CFP. 2352x1568px: 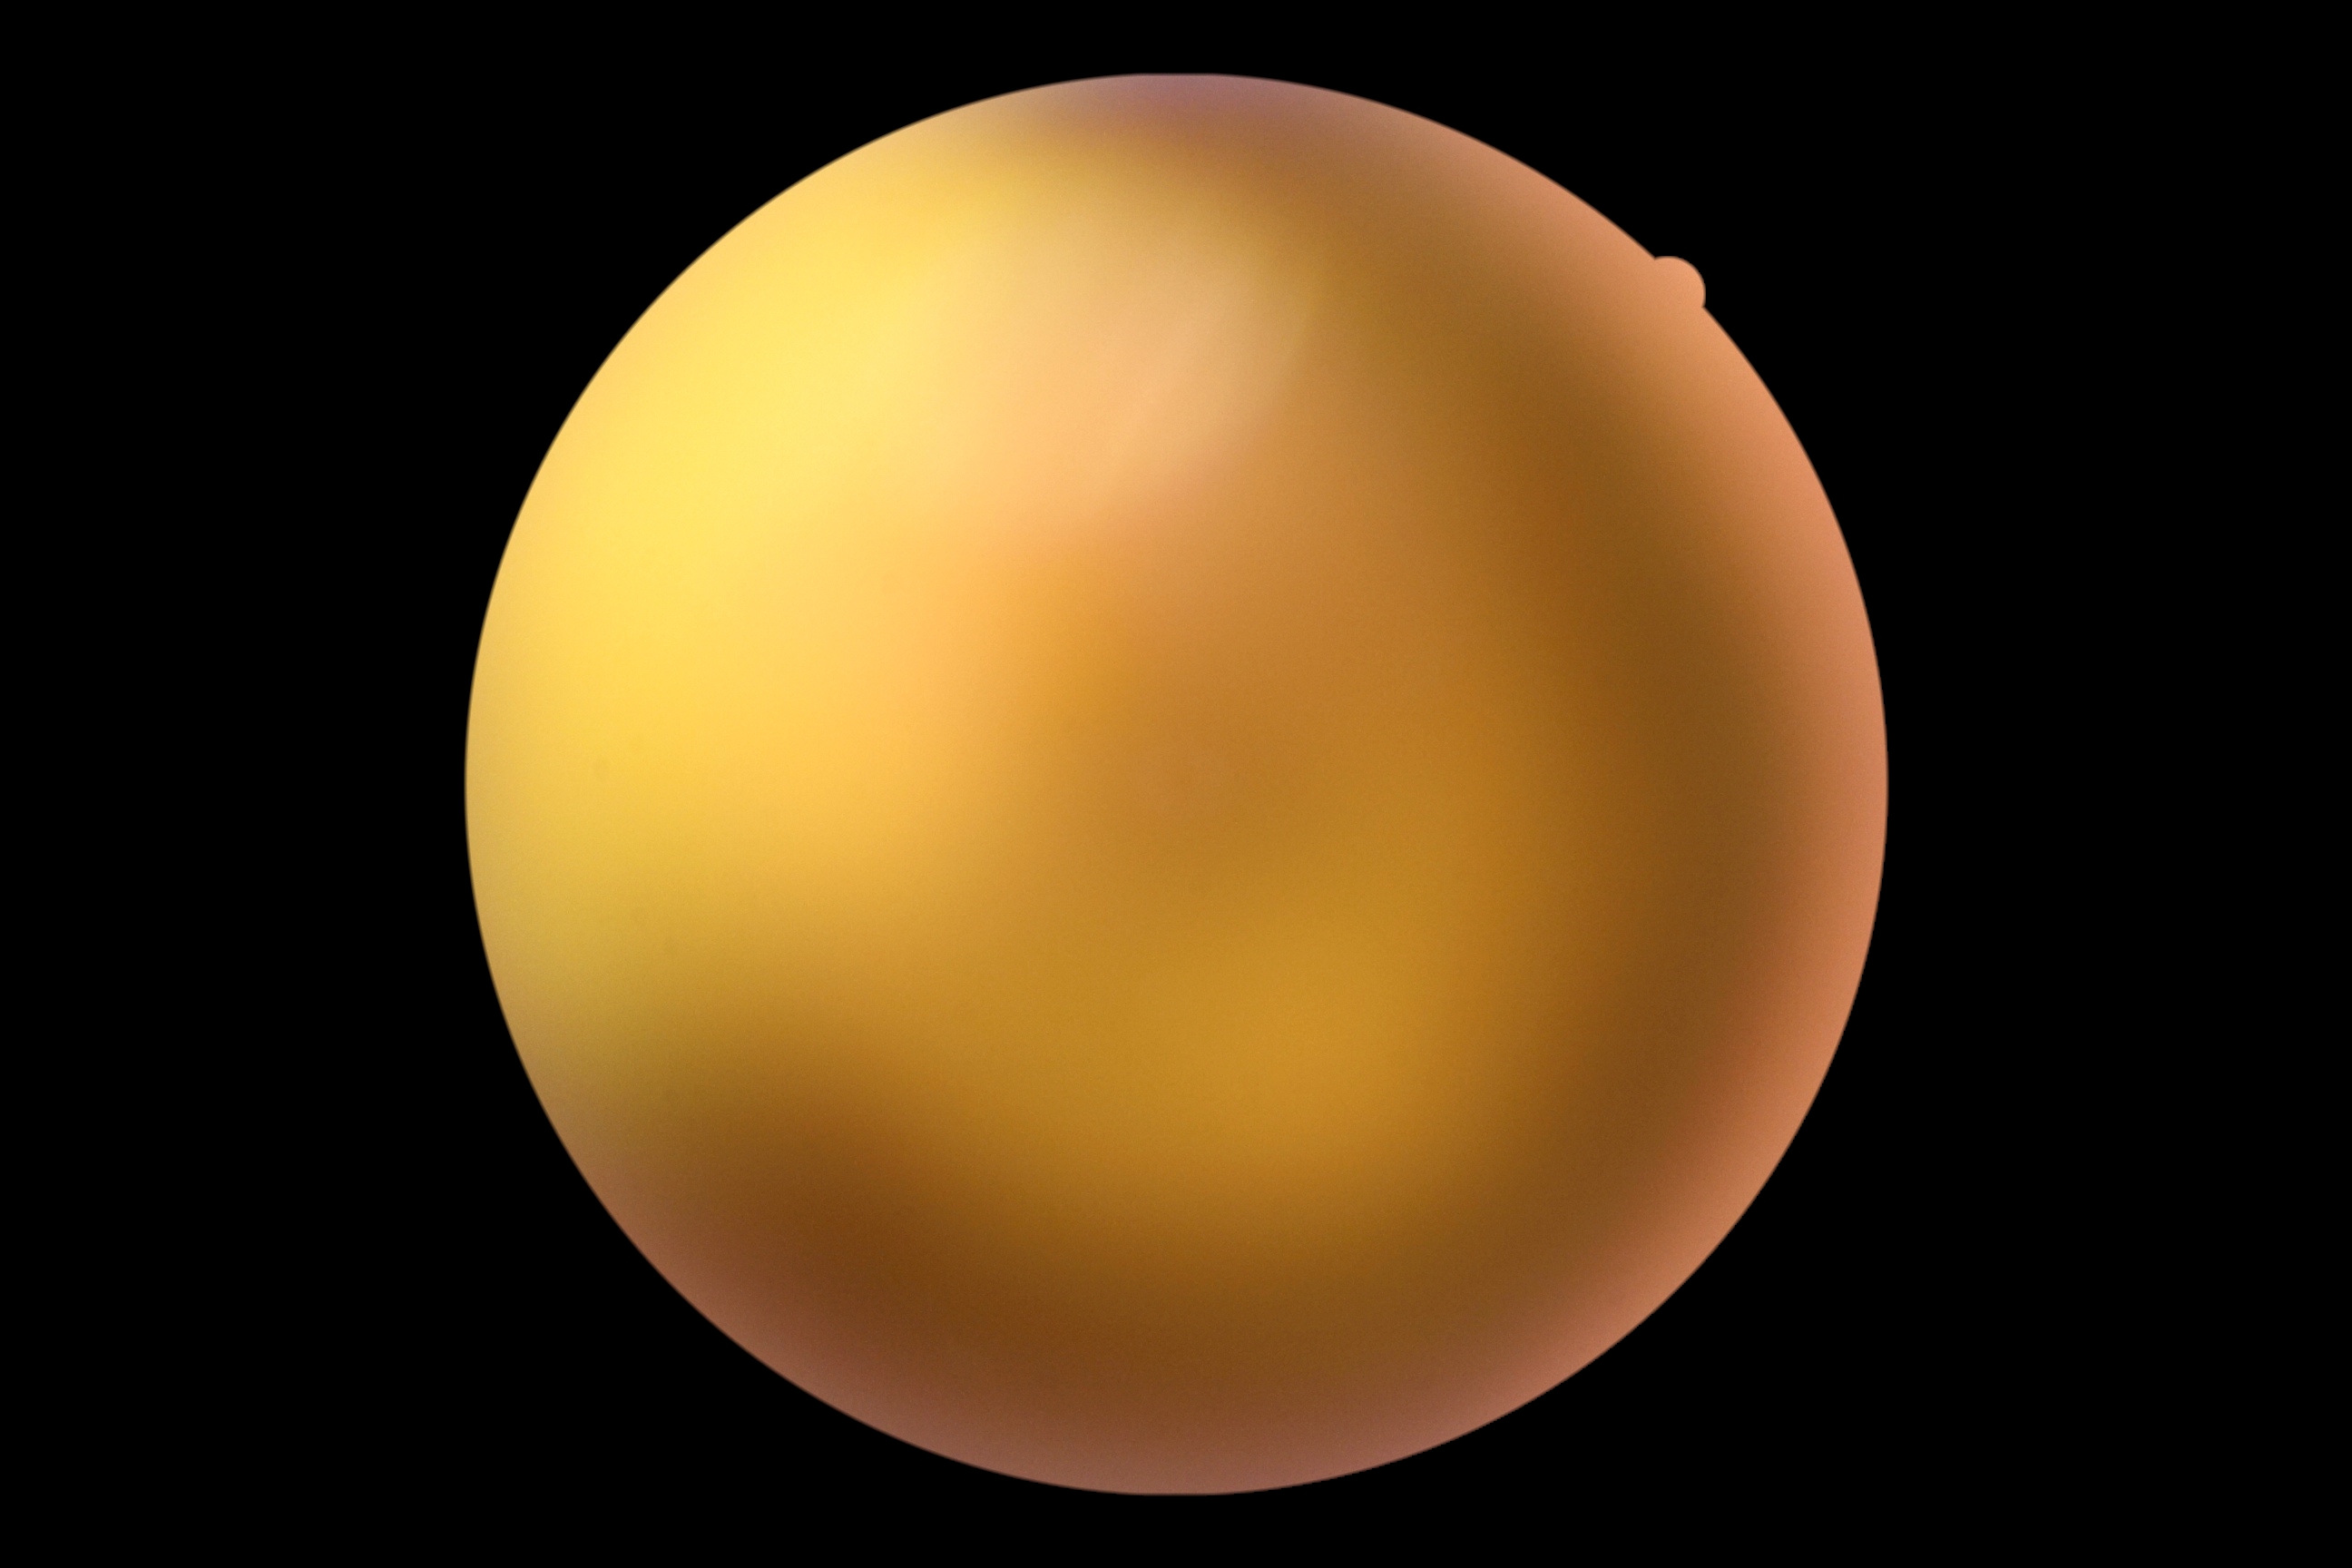 Retinopathy: ungradable.